Color fundus image, image size 2352x1568
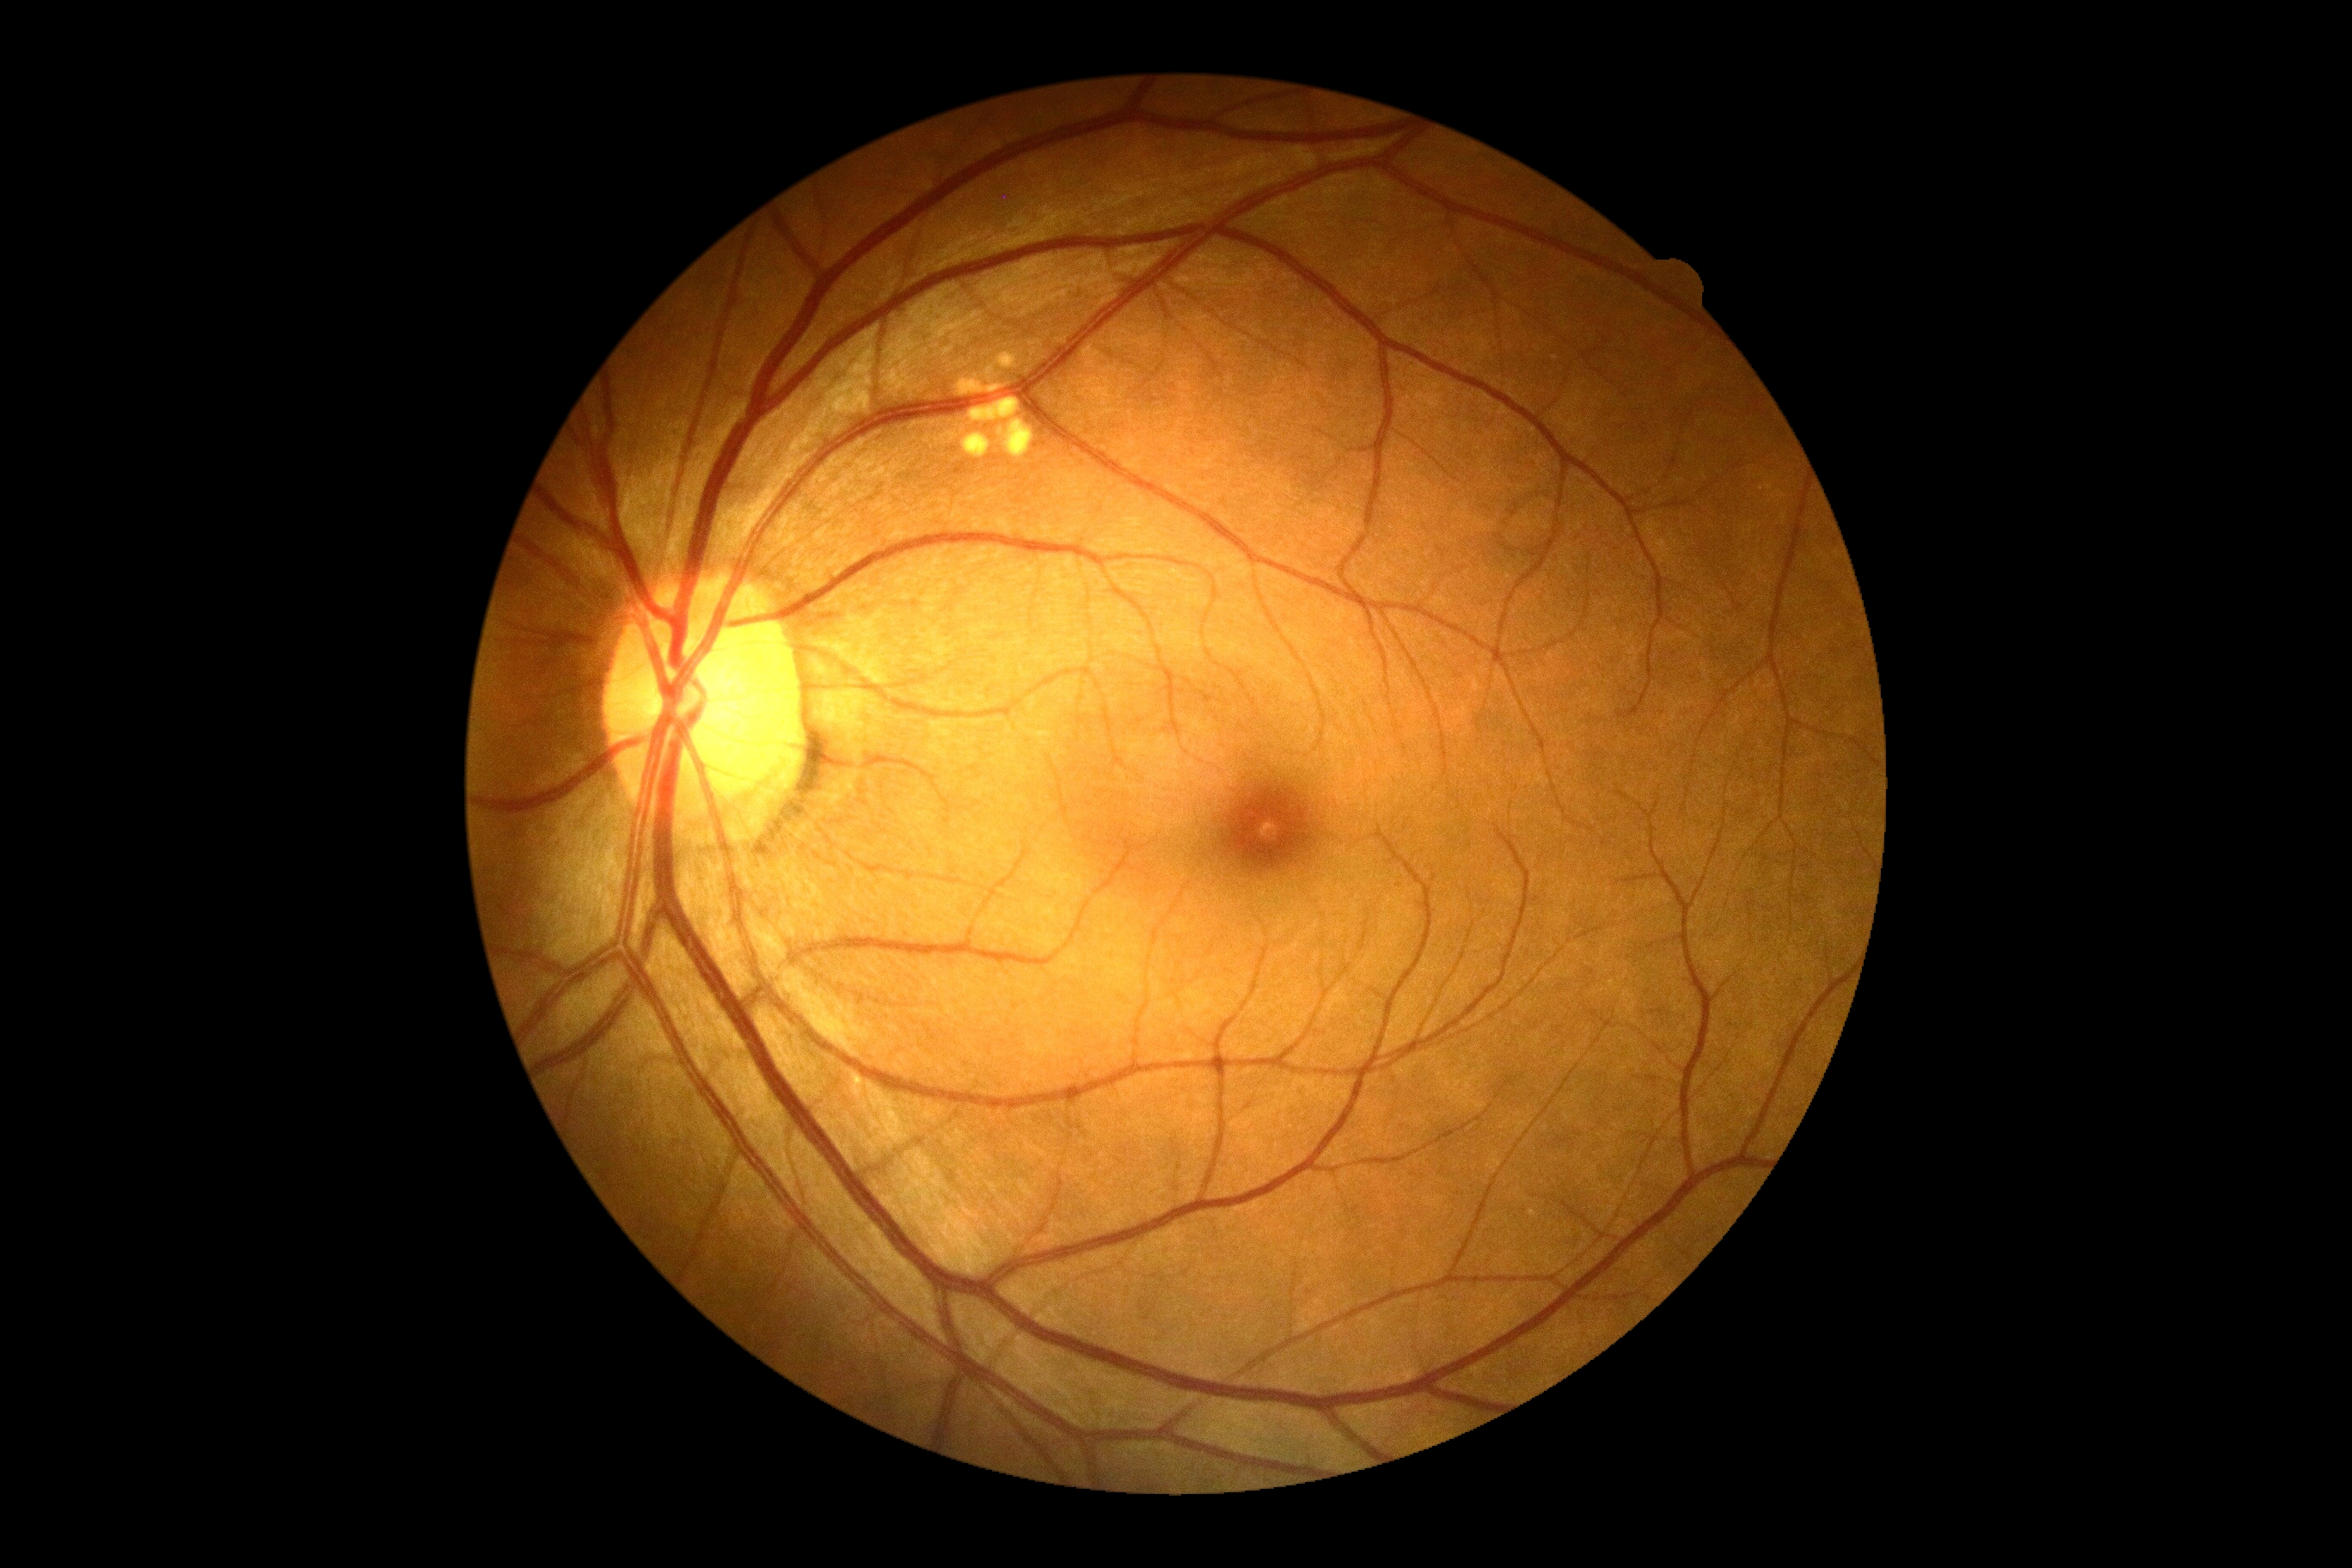
– diabetic retinopathy (DR): grade 0 (no apparent retinopathy)